Color fundus photograph: 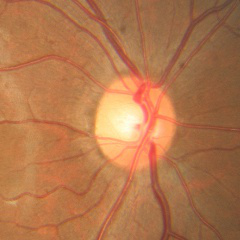
The image shows no glaucomatous changes.